640 x 480 pixels; captured with the Clarity RetCam 3 (130° field of view); infant wide-field retinal image — 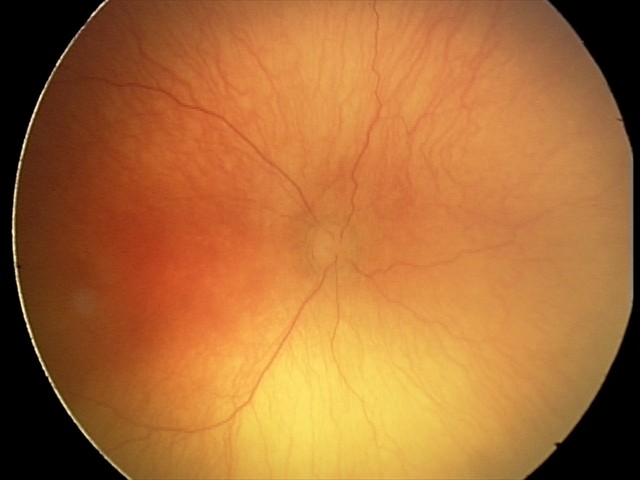
Assessment: aggressive ROP (A-ROP).